Retinal fundus photograph; 848 x 848 pixels; camera: NIDEK AFC-230; no pharmacologic dilation: 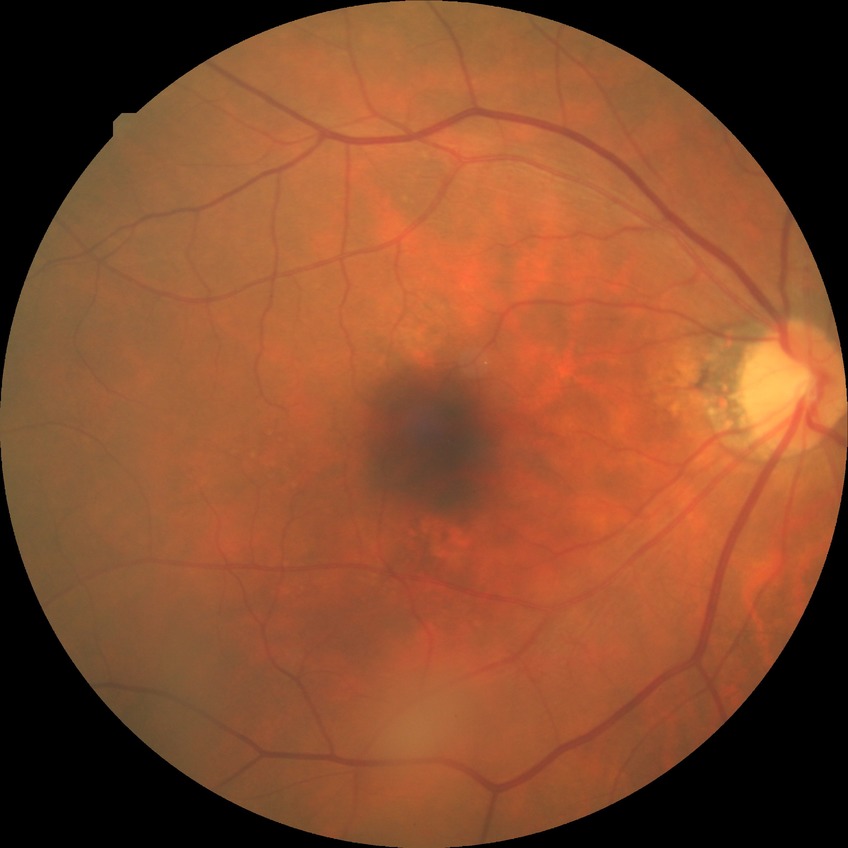

Modified Davis classification is no diabetic retinopathy.